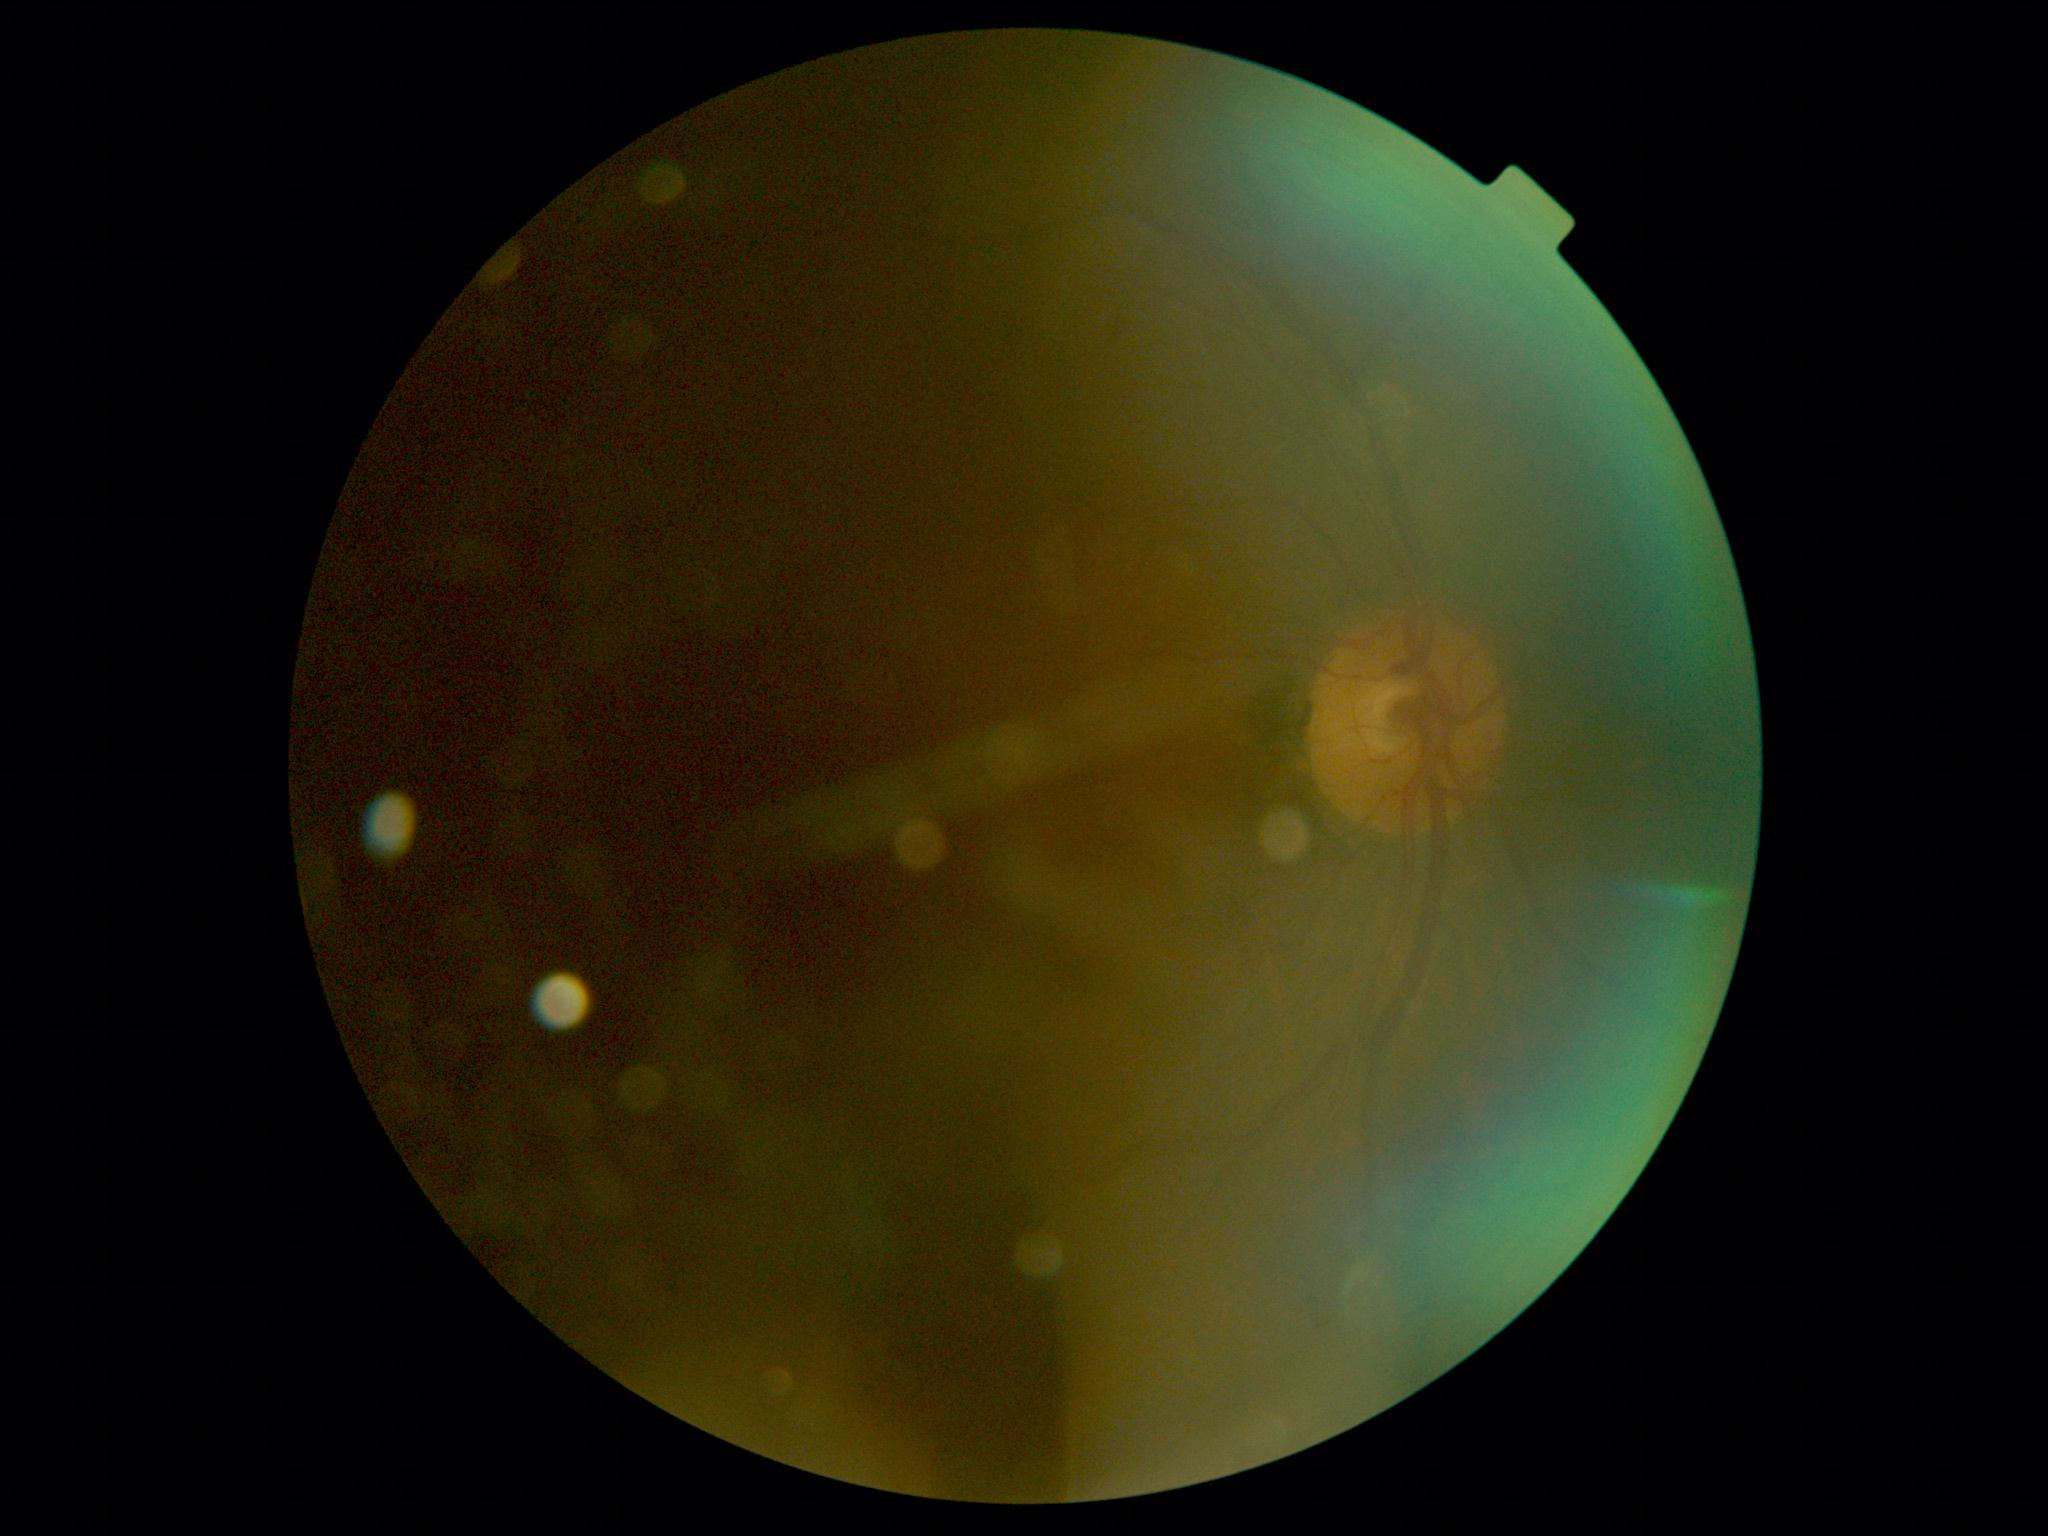 {
  "quality": "insufficient",
  "dr_grade": "ungradable"
}